45° field of view, fundus photo, NIDEK AFC-230 fundus camera, 848 by 848 pixels.
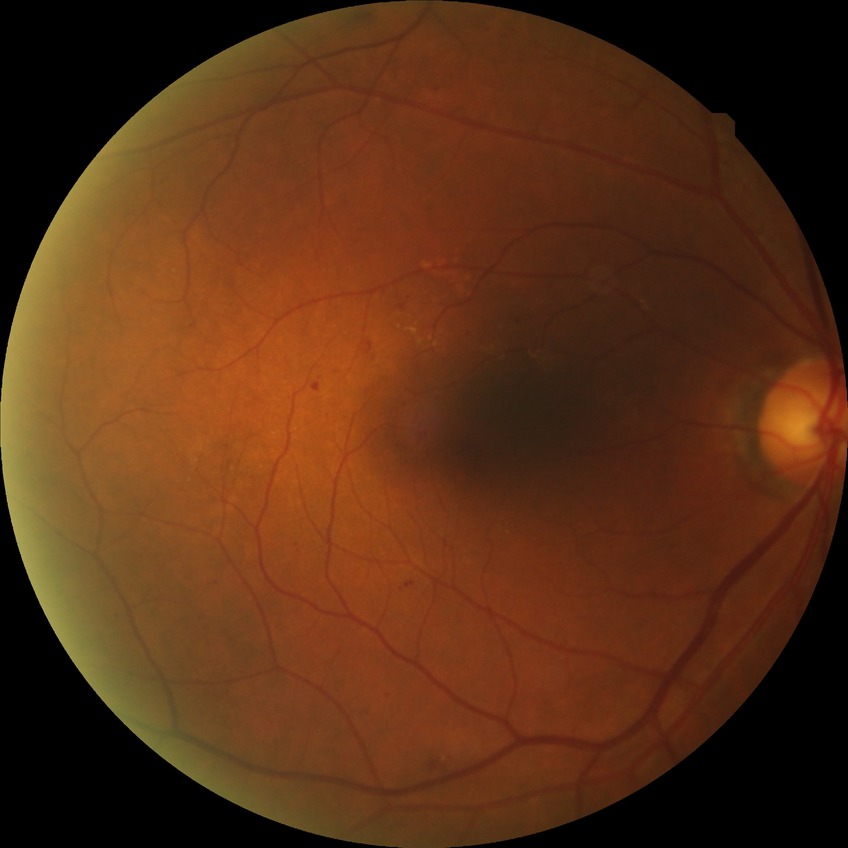 Davis grading: simple diabetic retinopathy.